Portable fundus camera image.
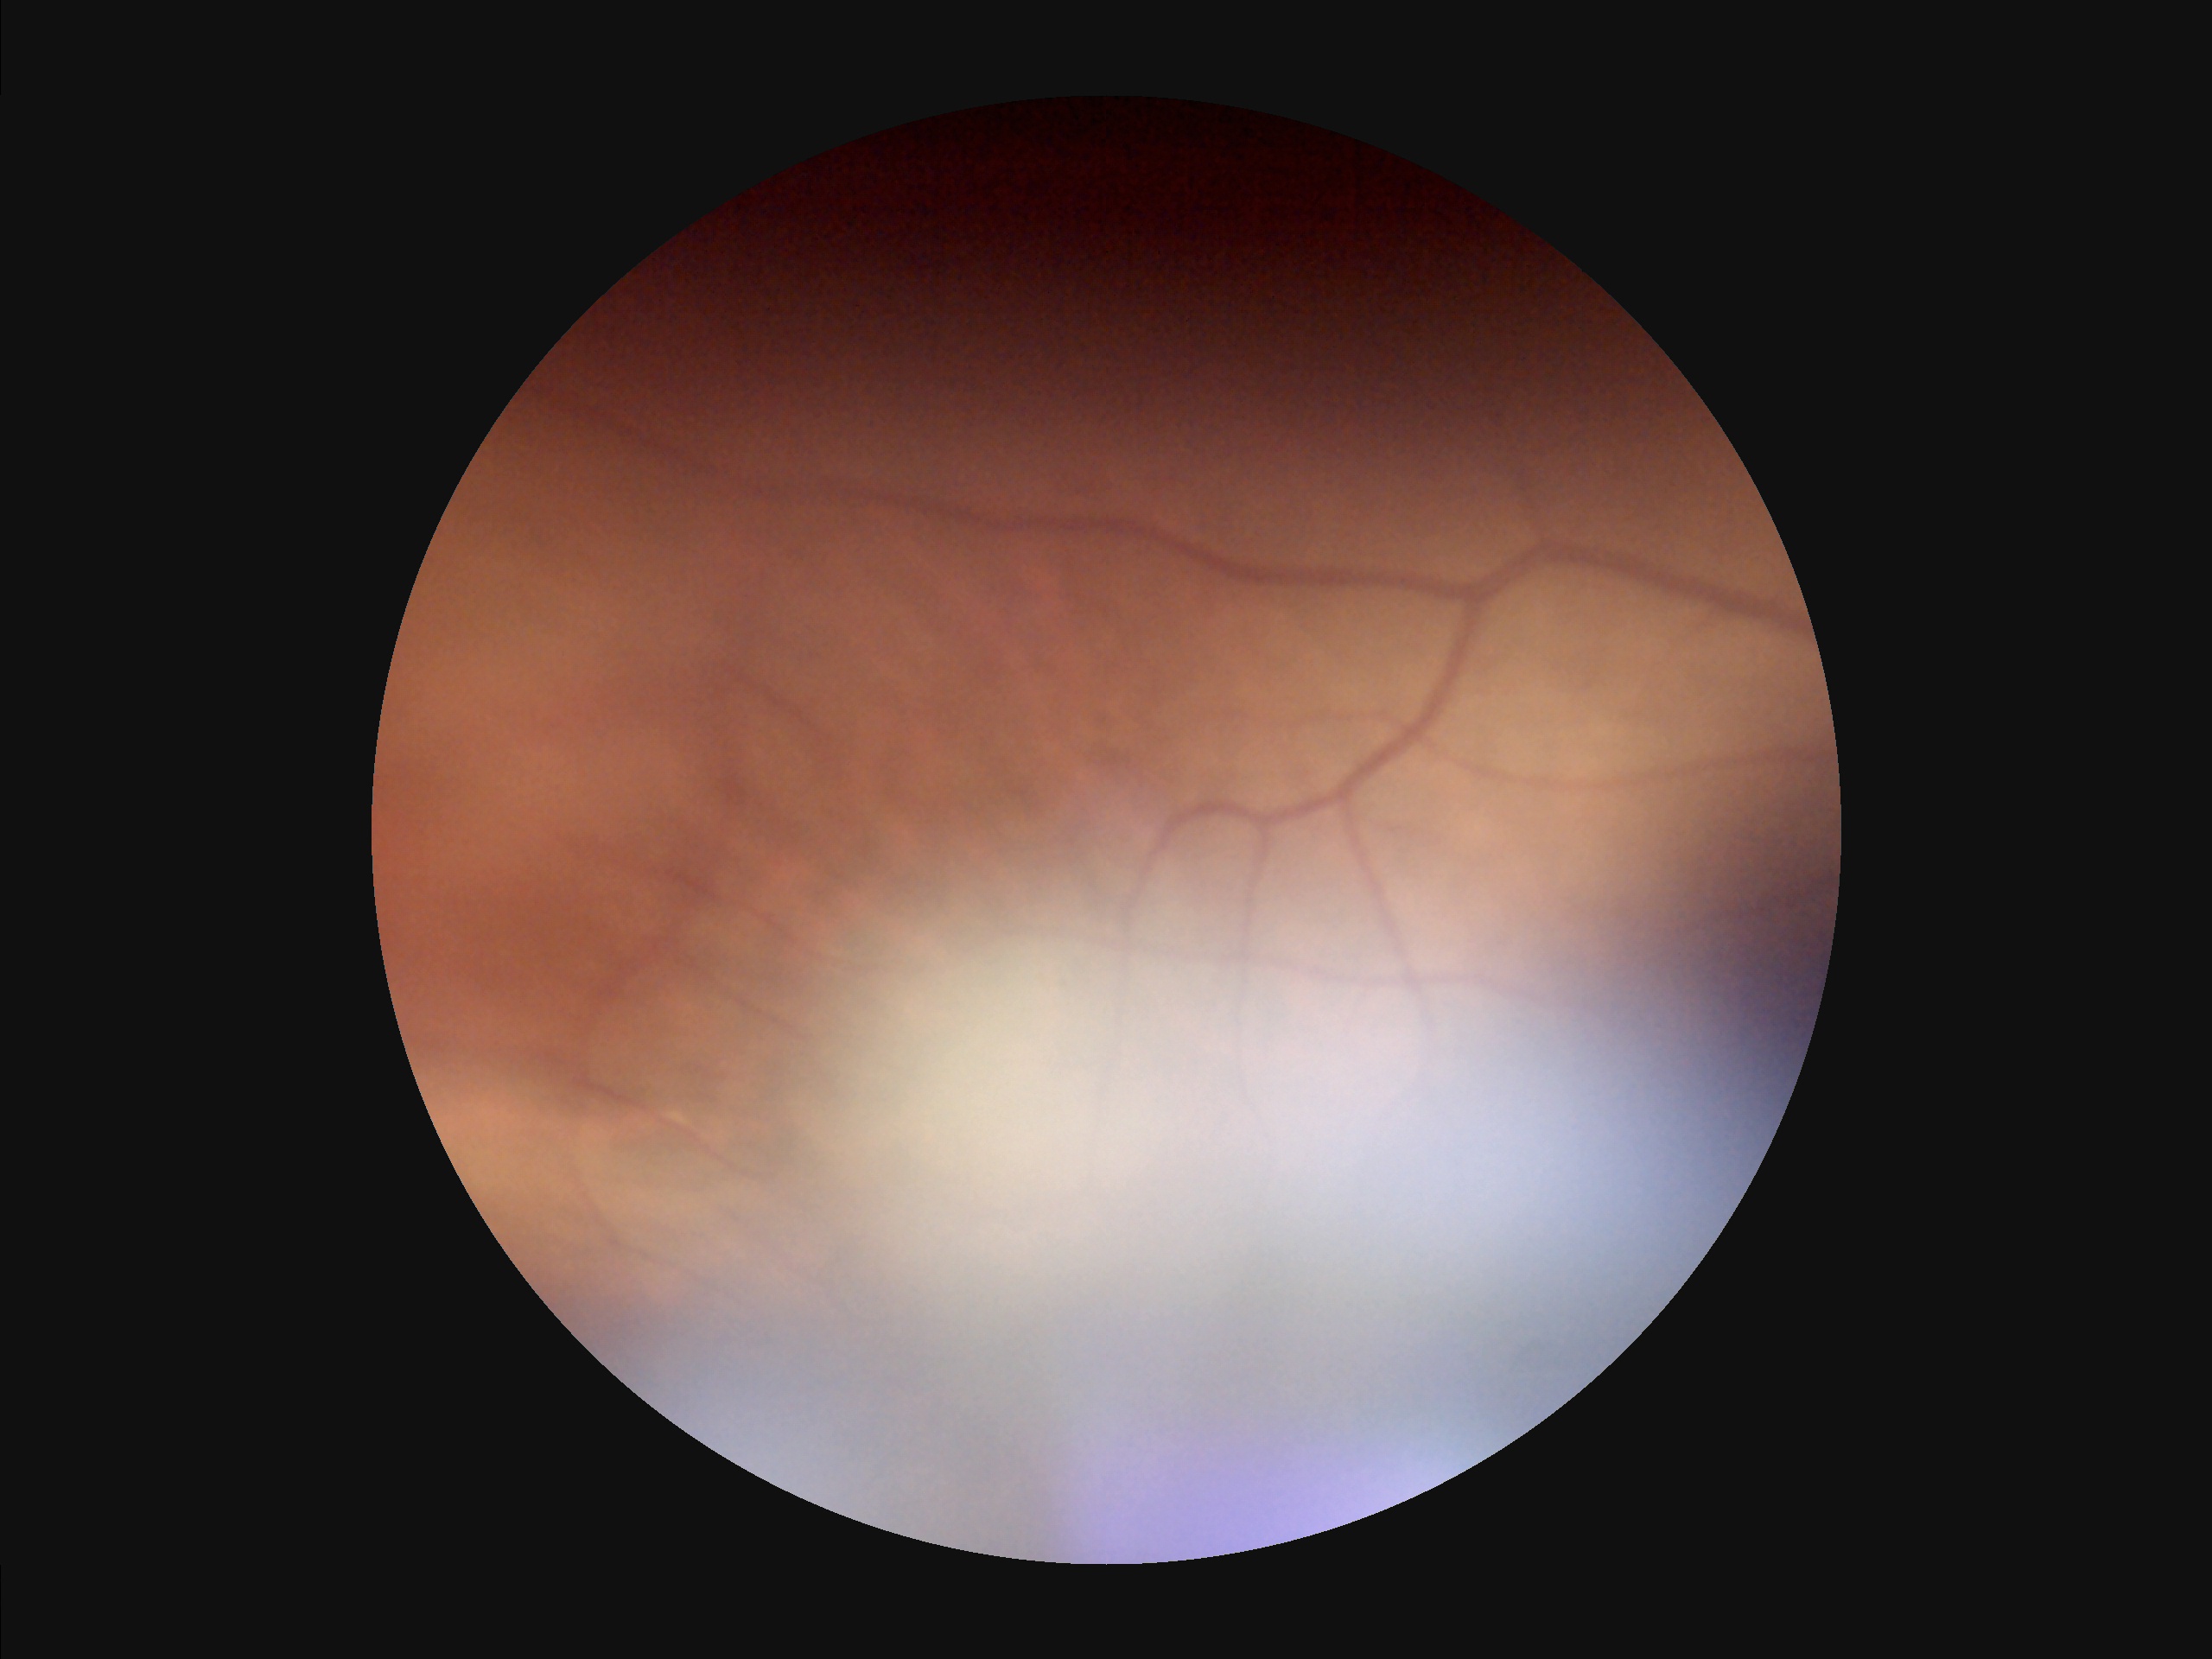
Image quality: contrast: low, vessels and details hard to distinguish | clarity: reduced sharpness with visible blur | illumination: uneven illumination or color cast | overall: poor and difficult to use diagnostically.